Without pupil dilation
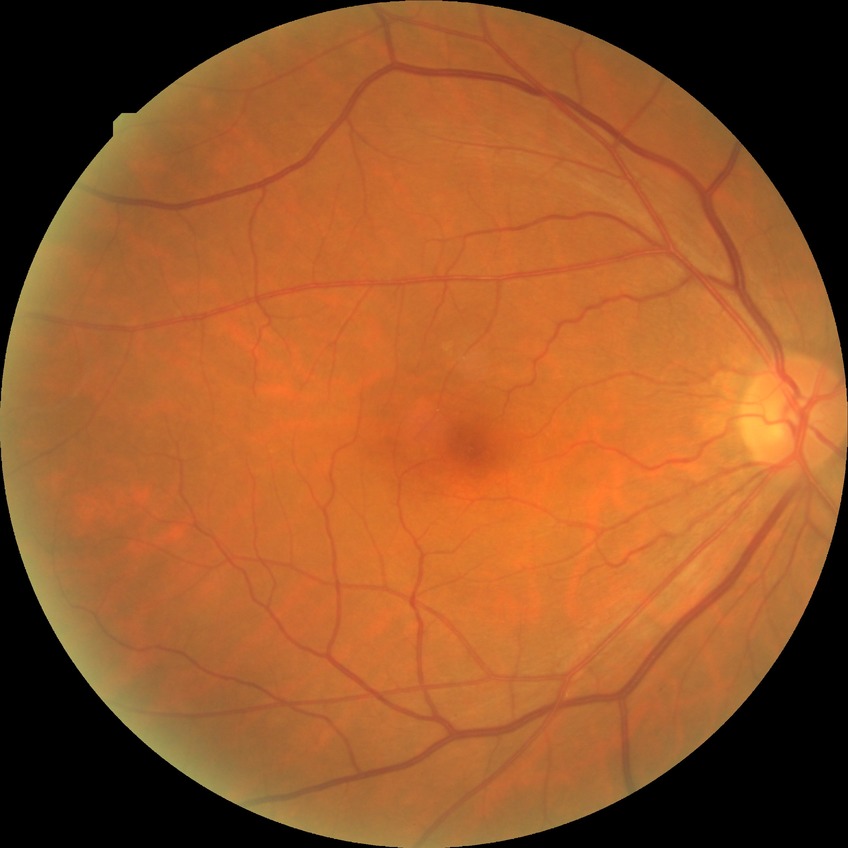
Modified Davis classification: no diabetic retinopathy.